Color fundus image:
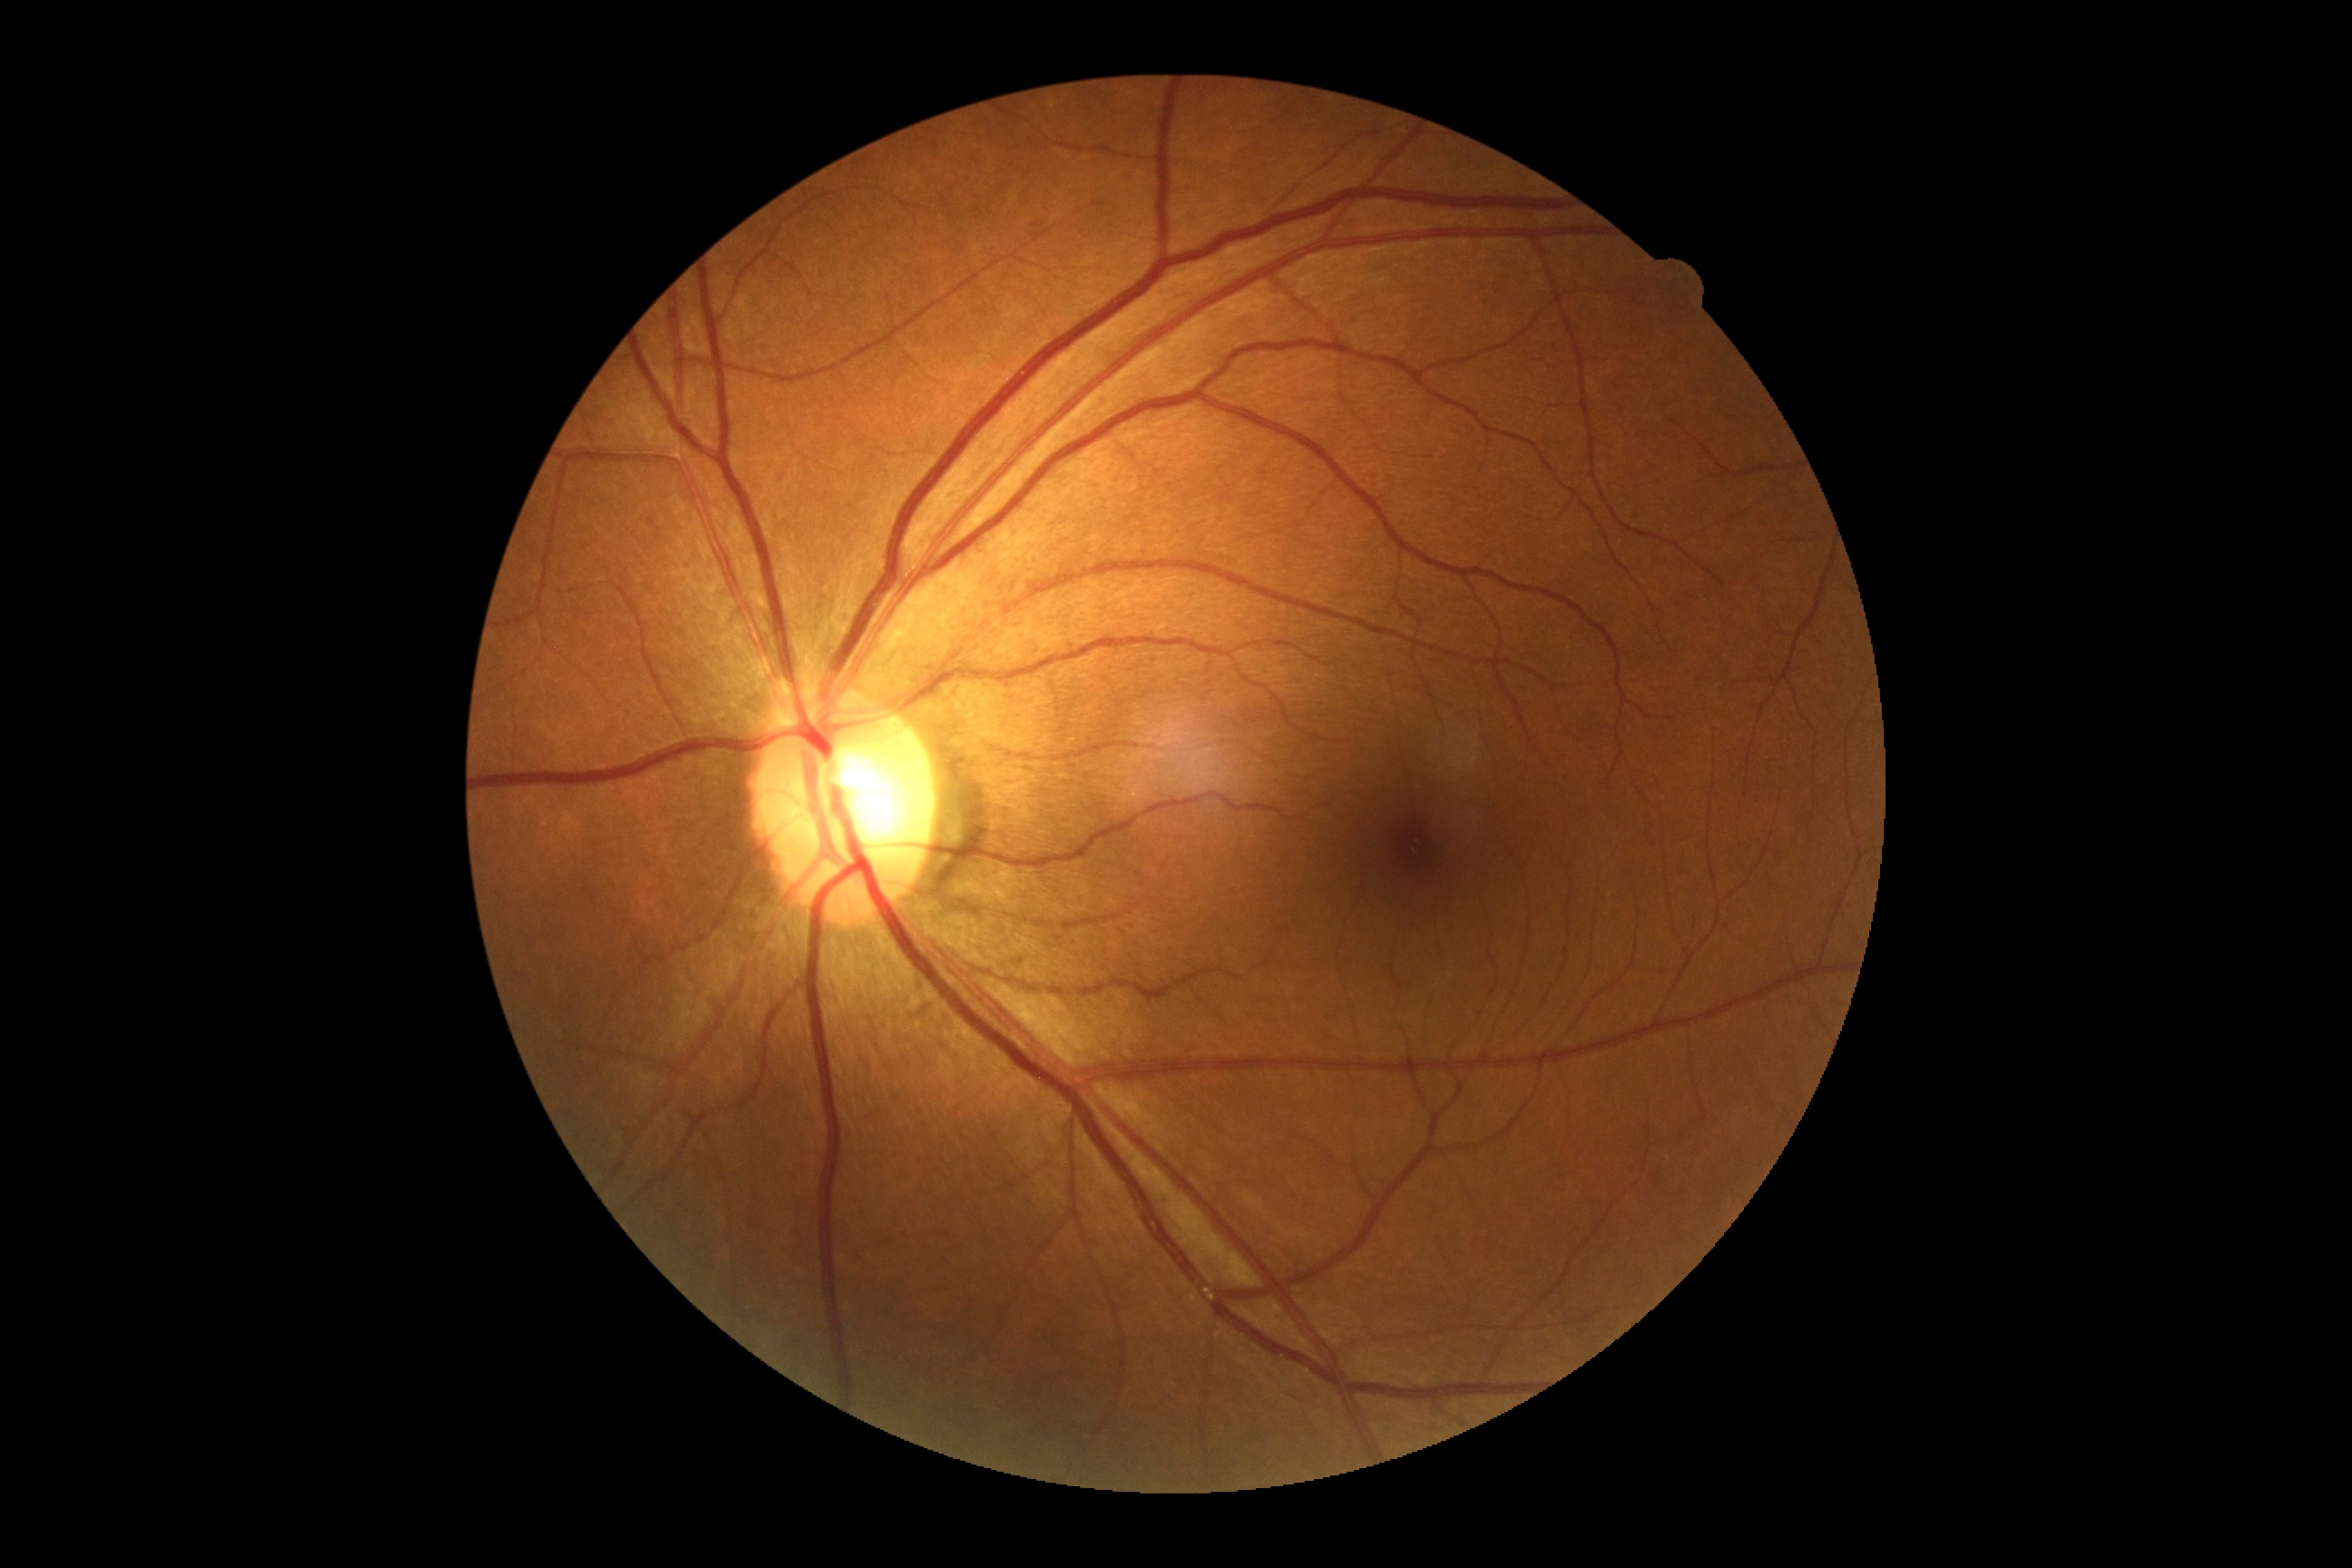

DR stage: grade 0 (no apparent retinopathy) — no visible signs of diabetic retinopathy.